Optic disc photograph; cropped from a 35-degree field of view
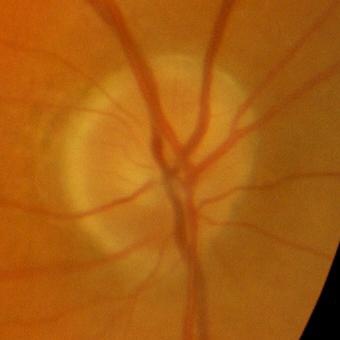 Diagnosis: no glaucomatous damage.